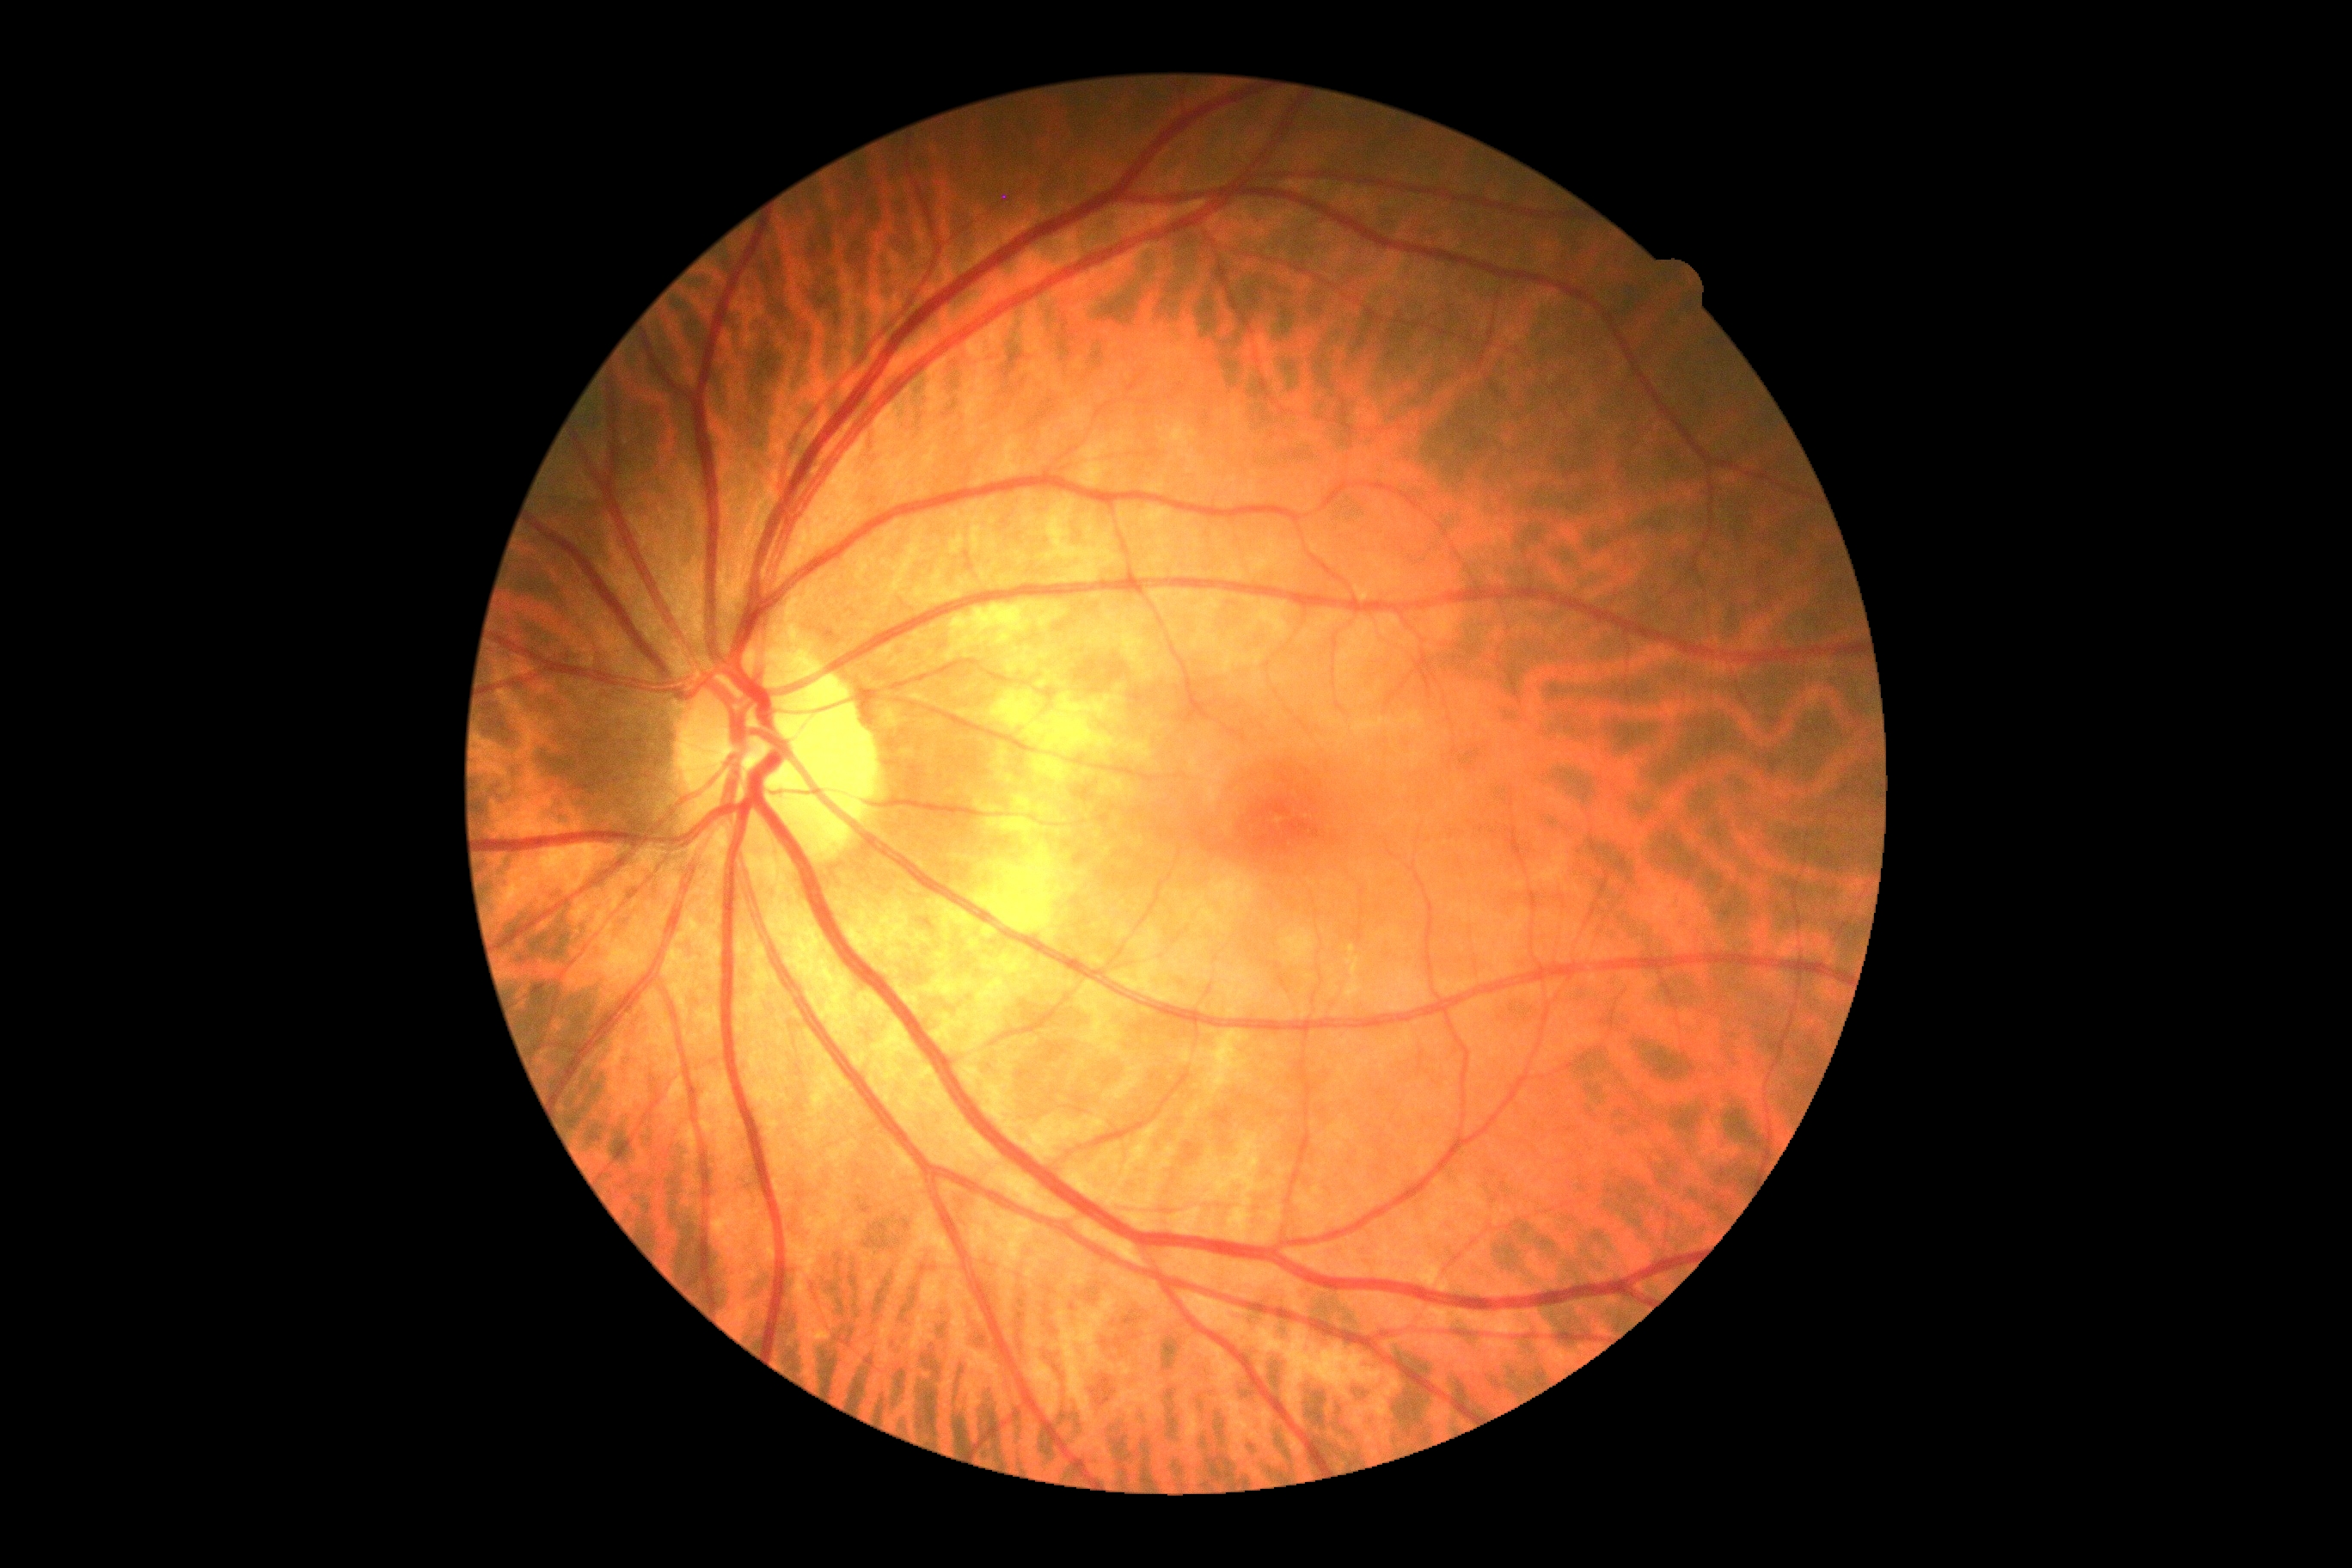

DR stage is grade 0 (no apparent retinopathy). No DR findings.